Pediatric wide-field fundus photograph · captured with the Clarity RetCam 3 (130° field of view).
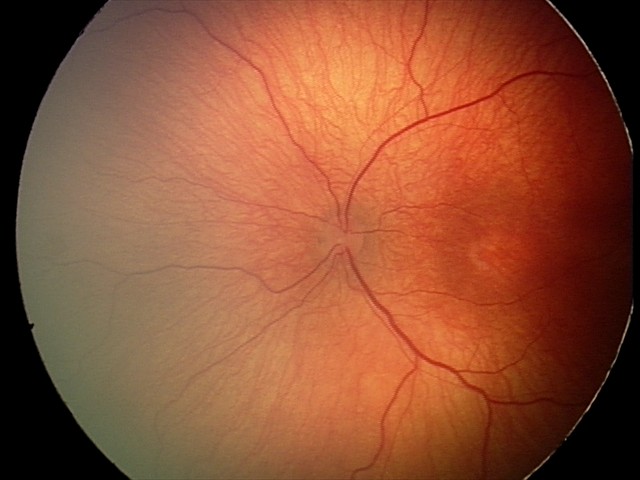 Assessment: ROP stage 2.